Cropped to the optic nerve head. 240 by 240 pixels — 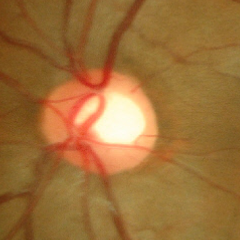
Optic disc photograph demonstrating no glaucomatous findings.